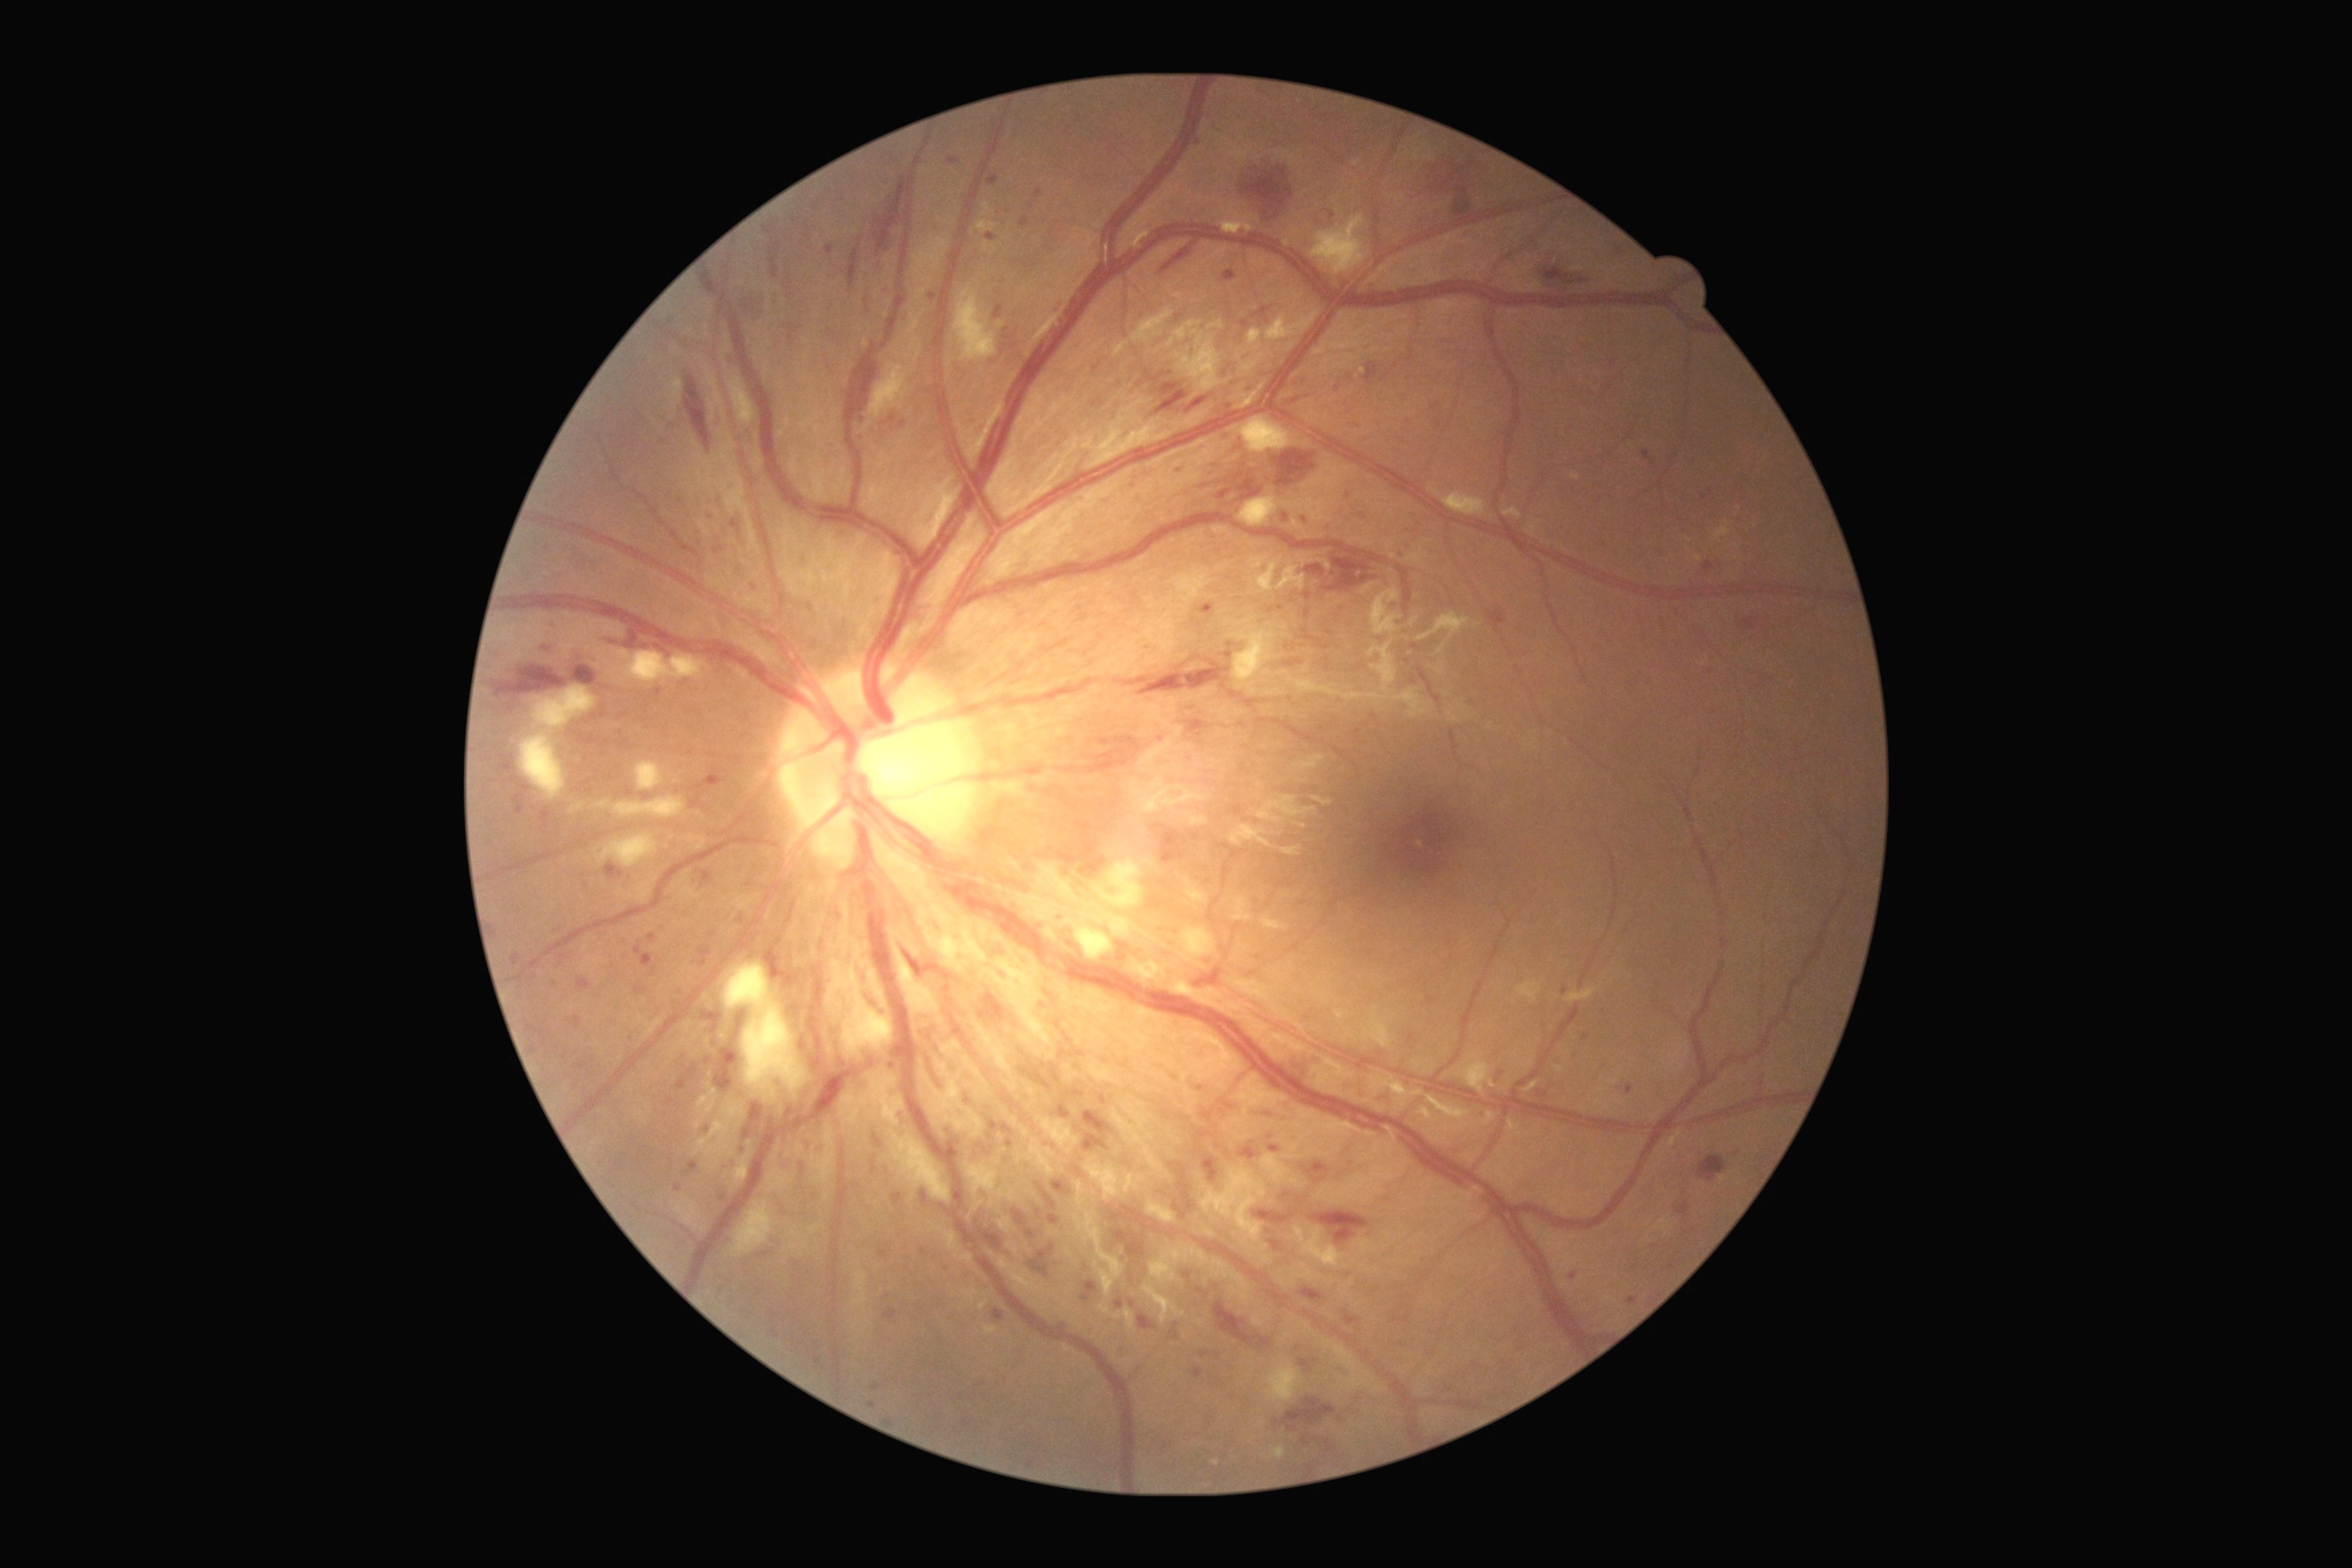

DR stage is grade 3; non-proliferative diabetic retinopathy.
MAs include lesions at 1206 1416 1213 1424; 1346 1313 1360 1326; 714 547 723 554; 1291 384 1300 391; 1048 1215 1061 1226; 694 946 712 968; 988 175 999 186; 1117 1351 1126 1362; 1248 387 1253 395; 1115 1300 1124 1309; 698 872 714 887.
Small MAs approximately at [901,1117]; [513,780]; [678,1187]; [1042,1464]; [1577,1054]; [545,1024]; [708,1061].